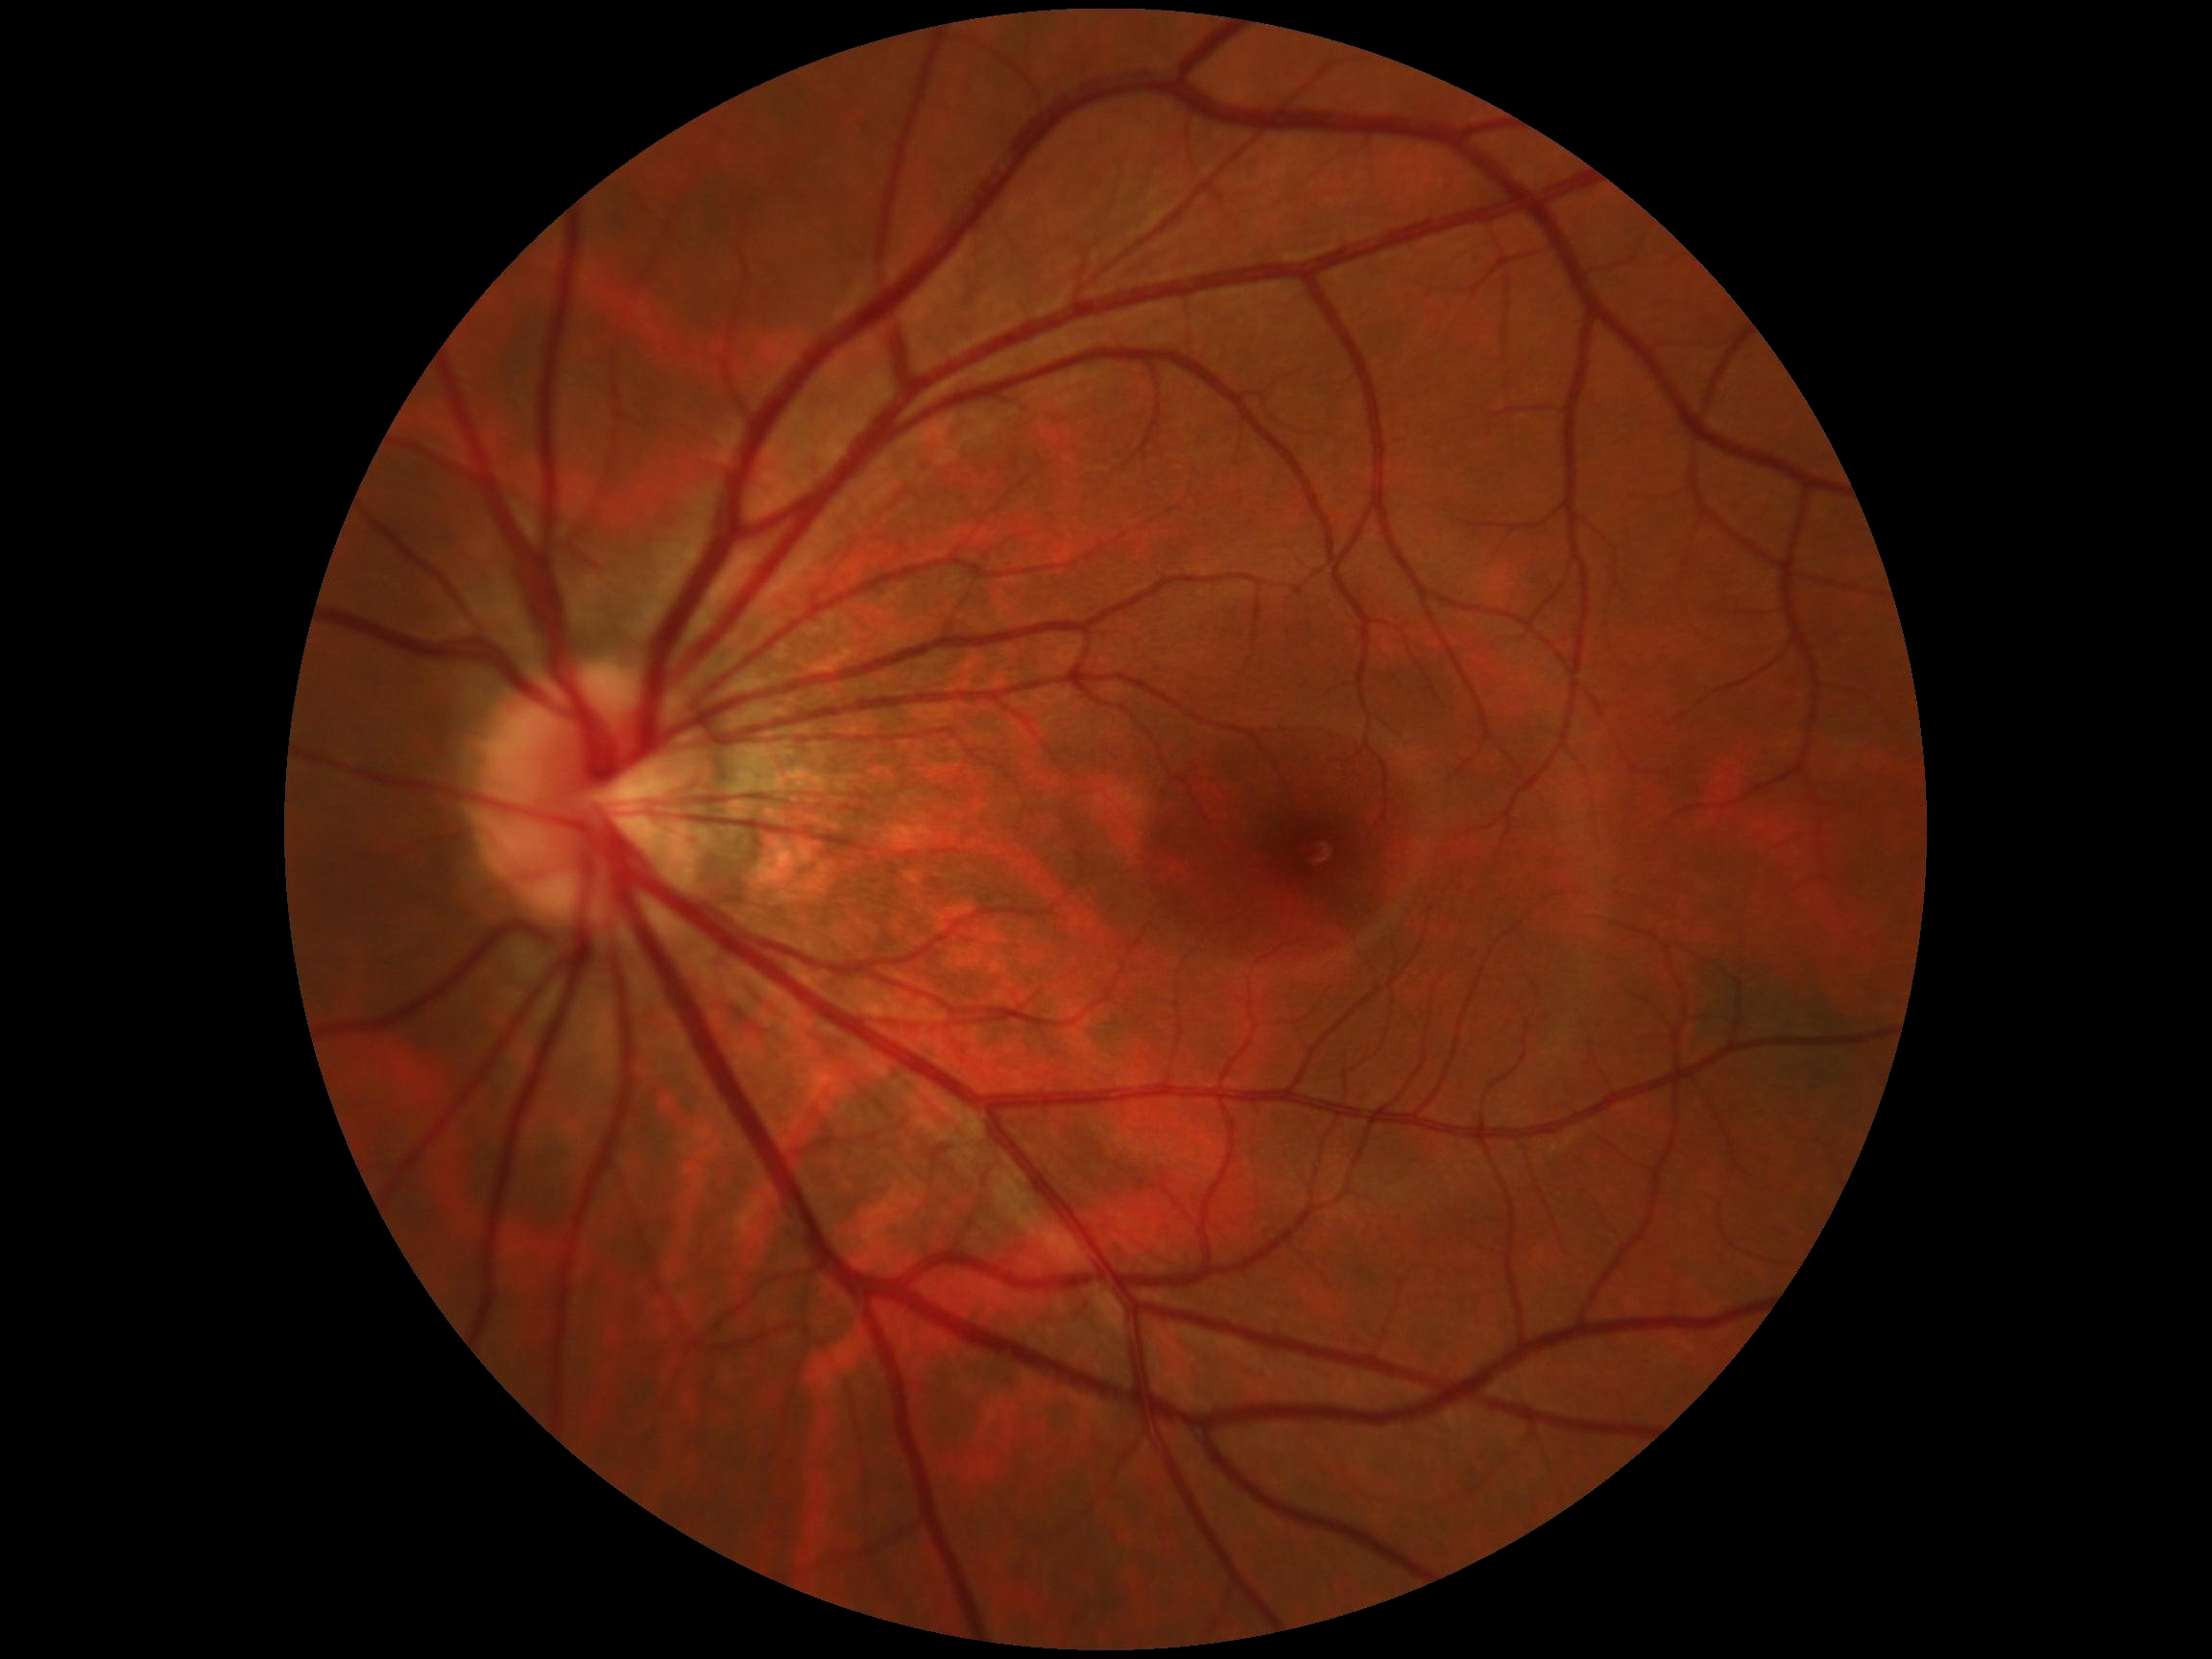

Diabetic retinopathy: no apparent diabetic retinopathy (grade 0). No apparent diabetic retinopathy.